Ultra-widefield fundus photograph: 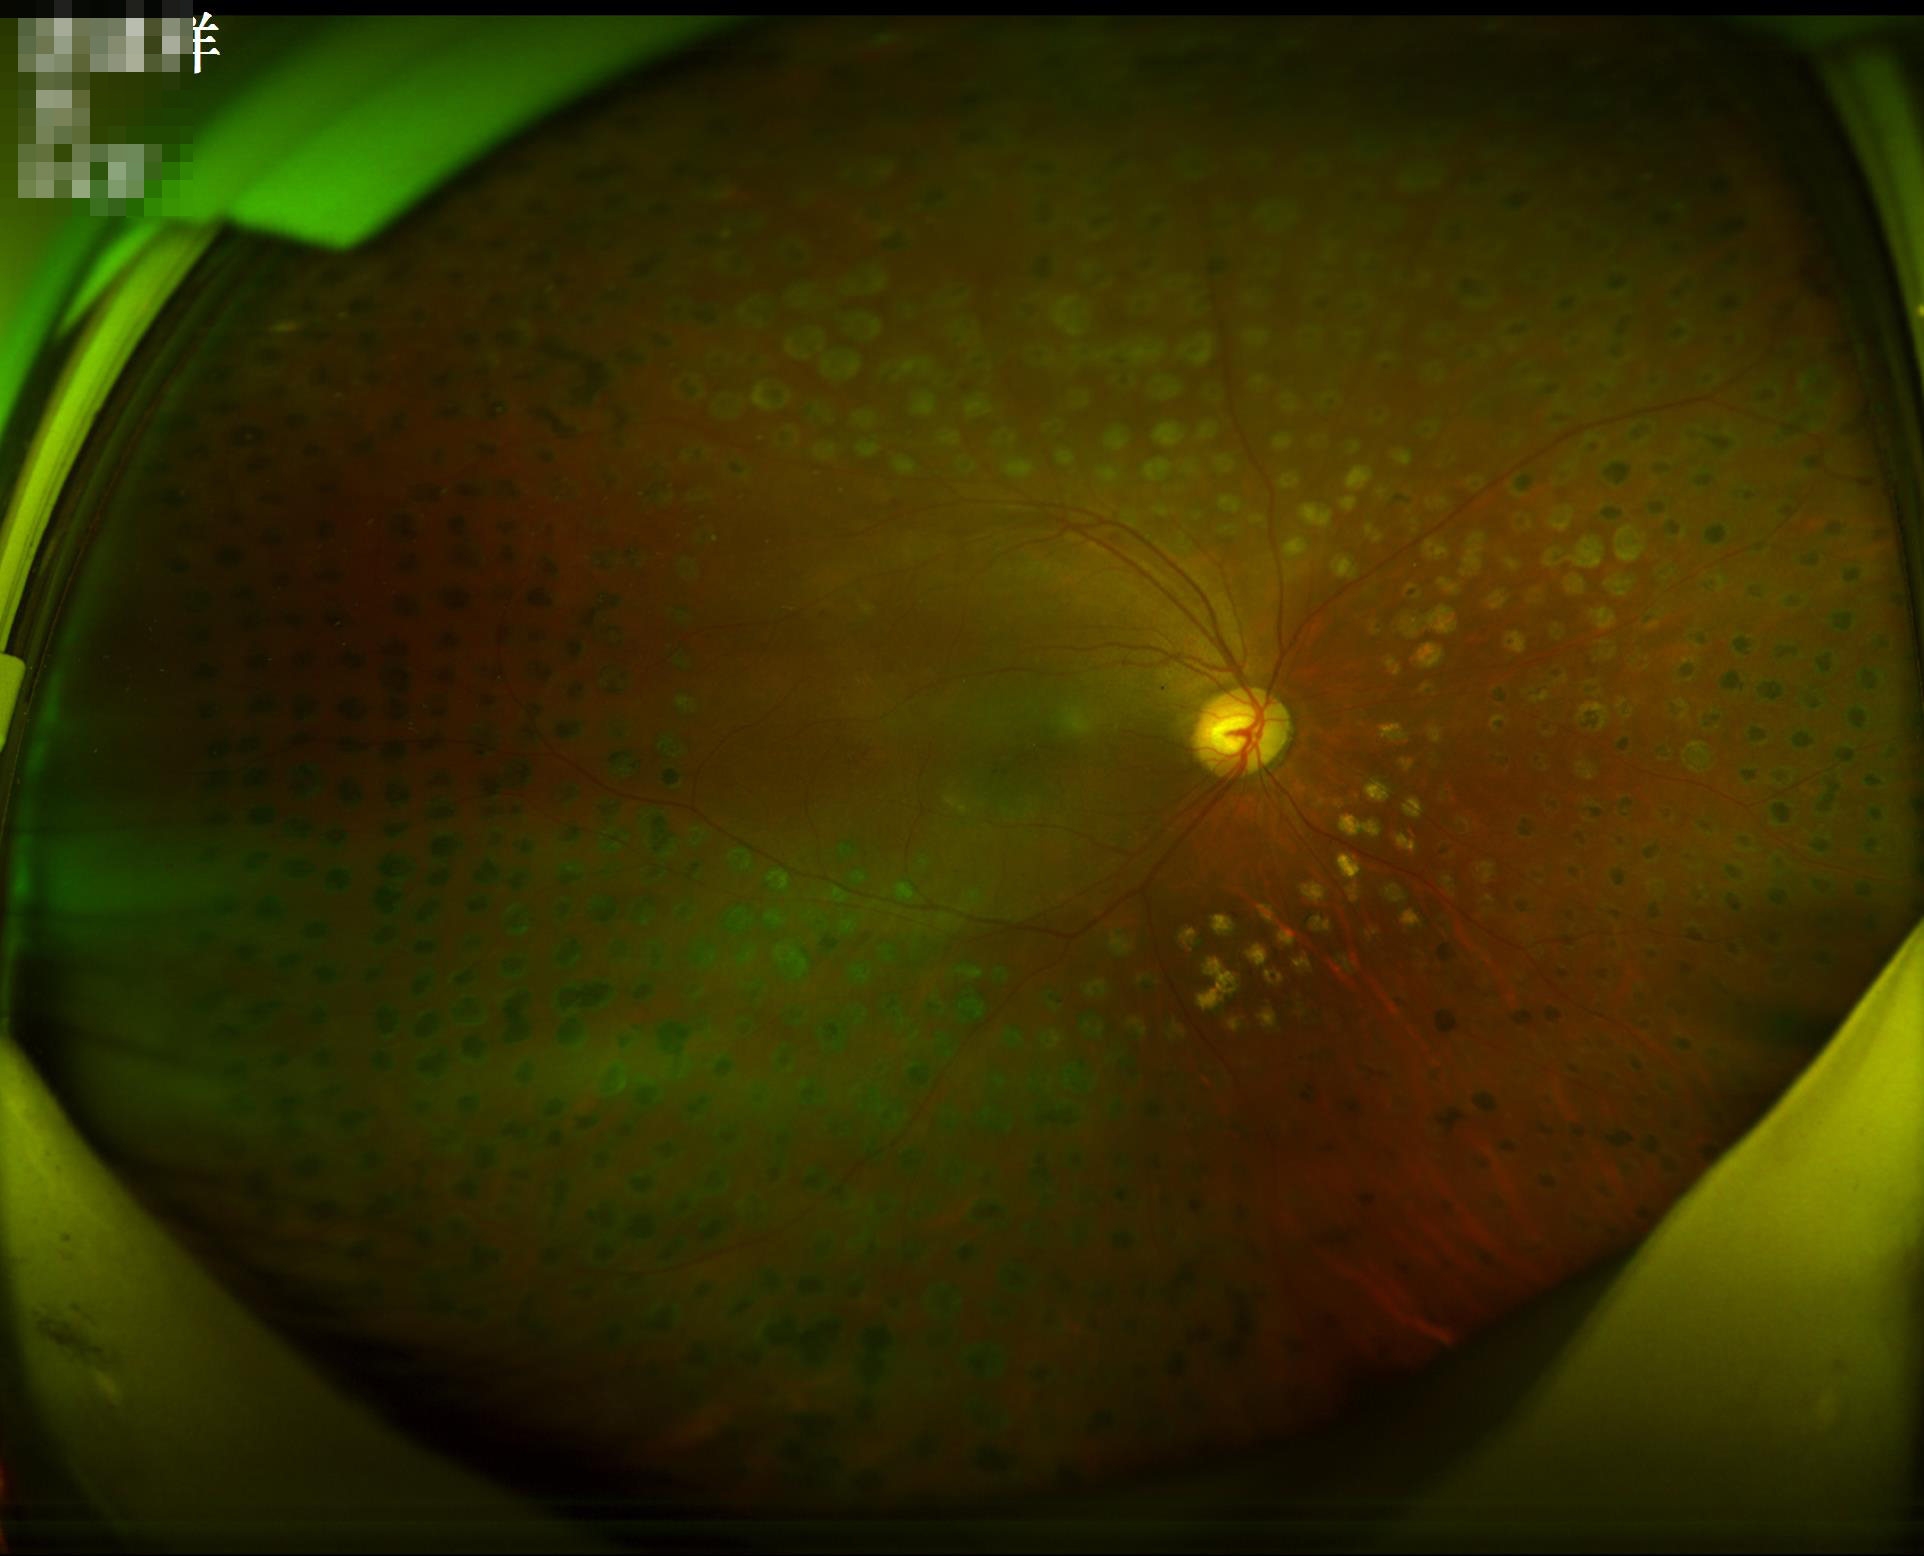

Contrast = good; Overall = adequate; Illumination/color = uneven; Sharpness = out of focus.